Wide-field fundus photograph of an infant. 1440 x 1080 pixels — 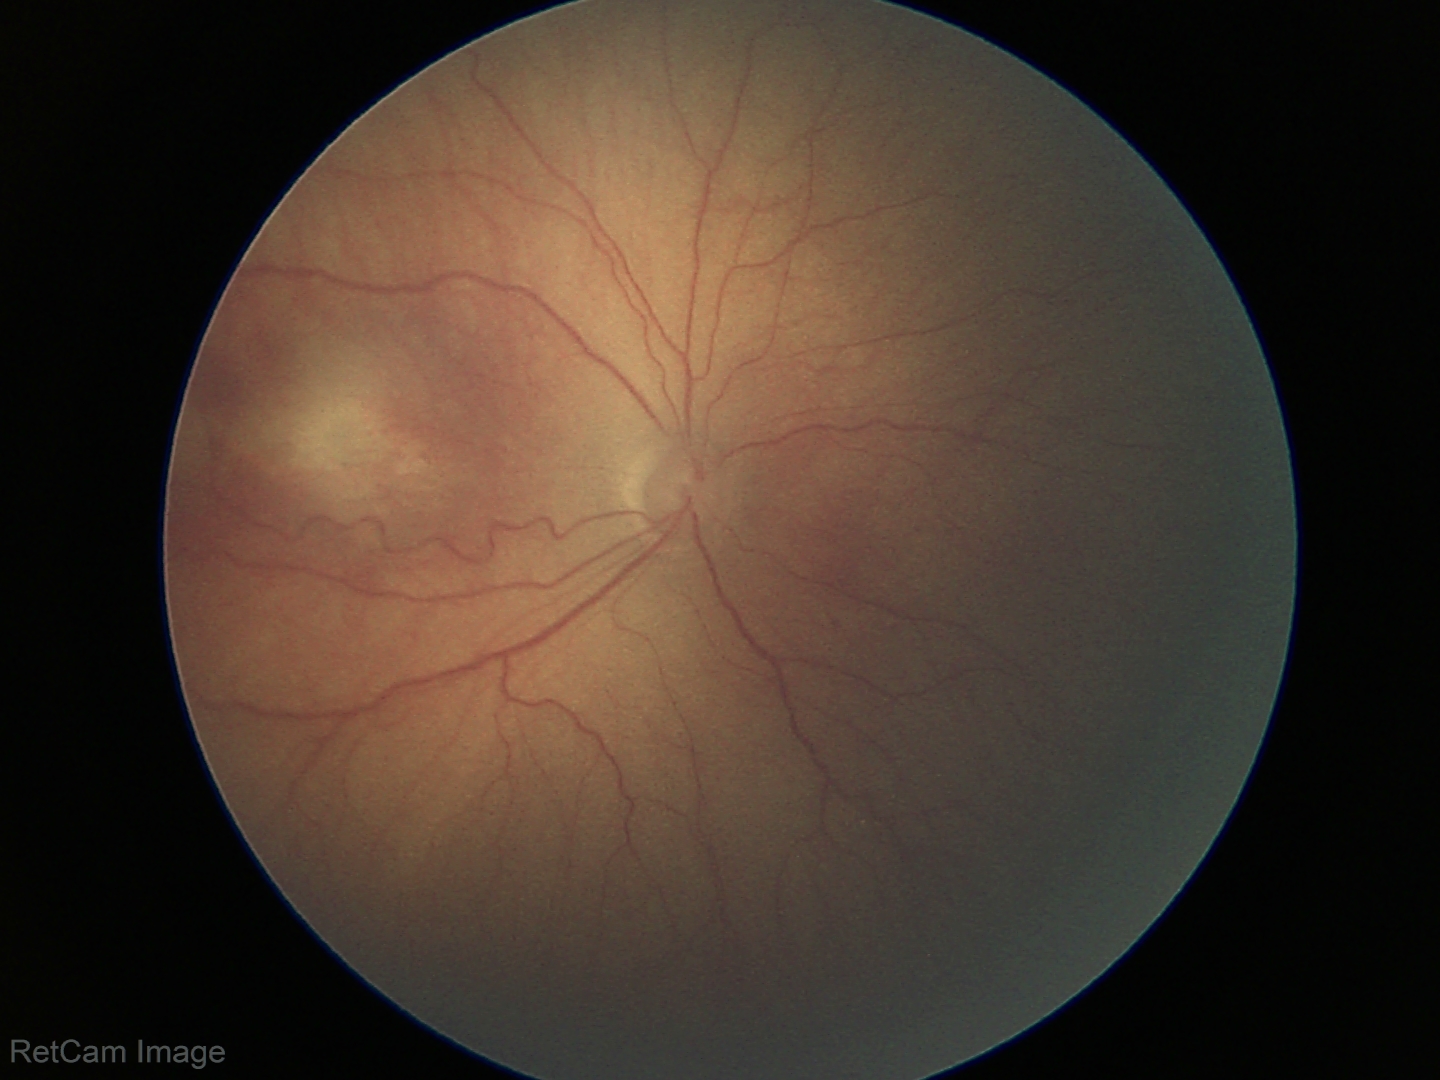

Q: What is the screening diagnosis?
A: ROP stage 3